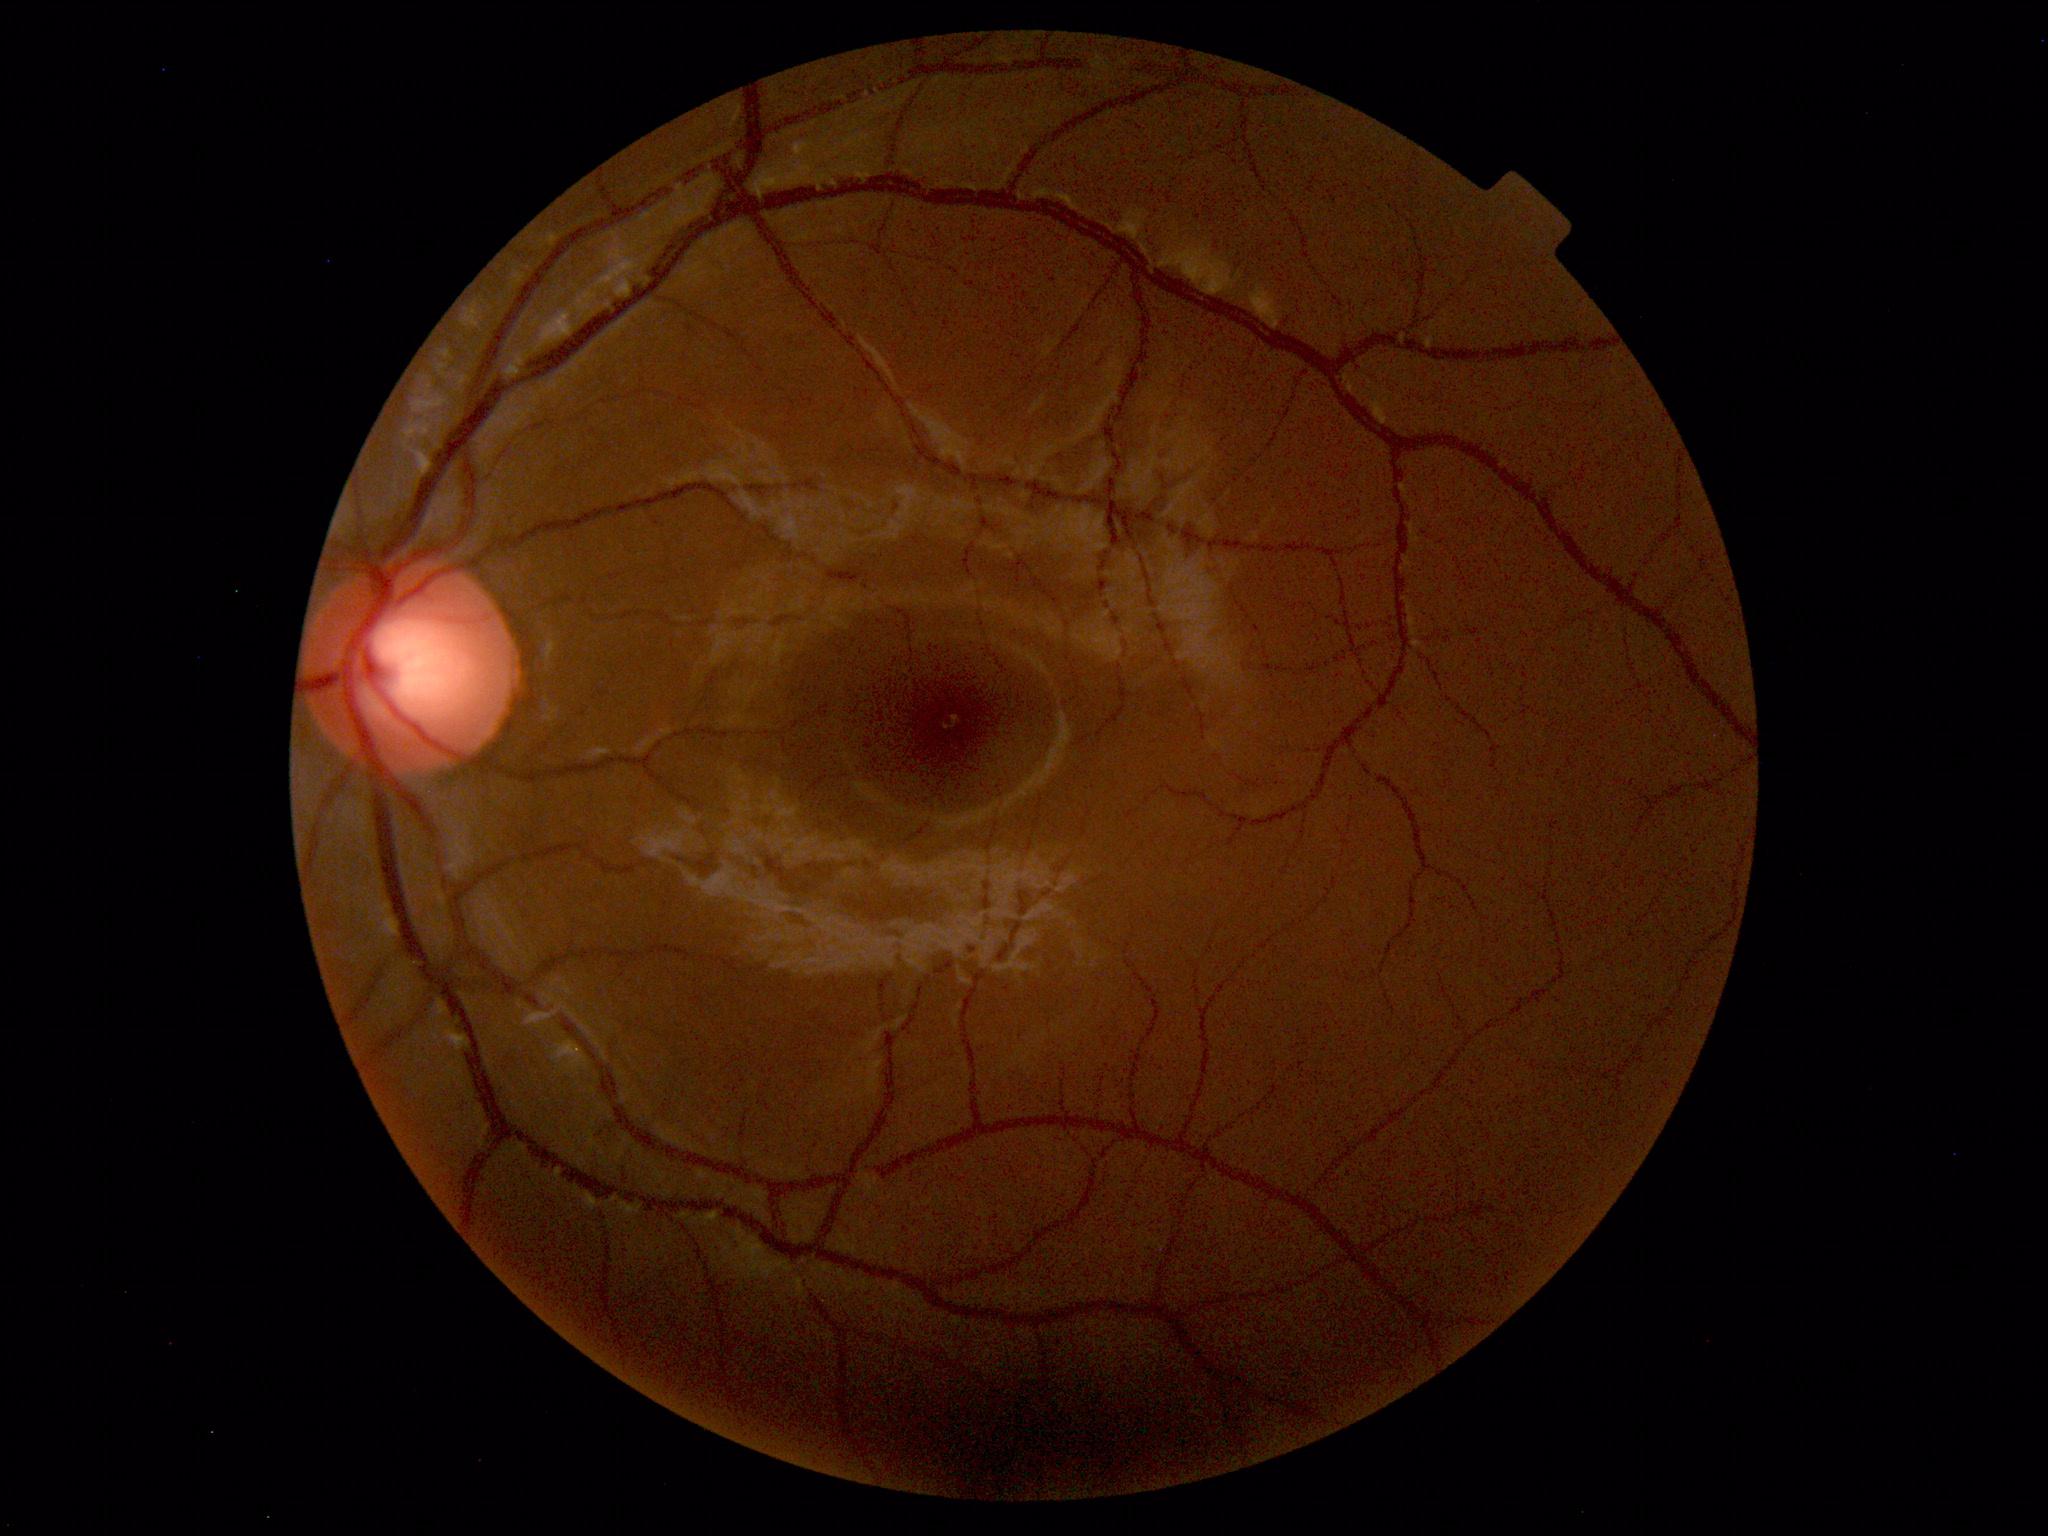 Normal color fundus photograph.